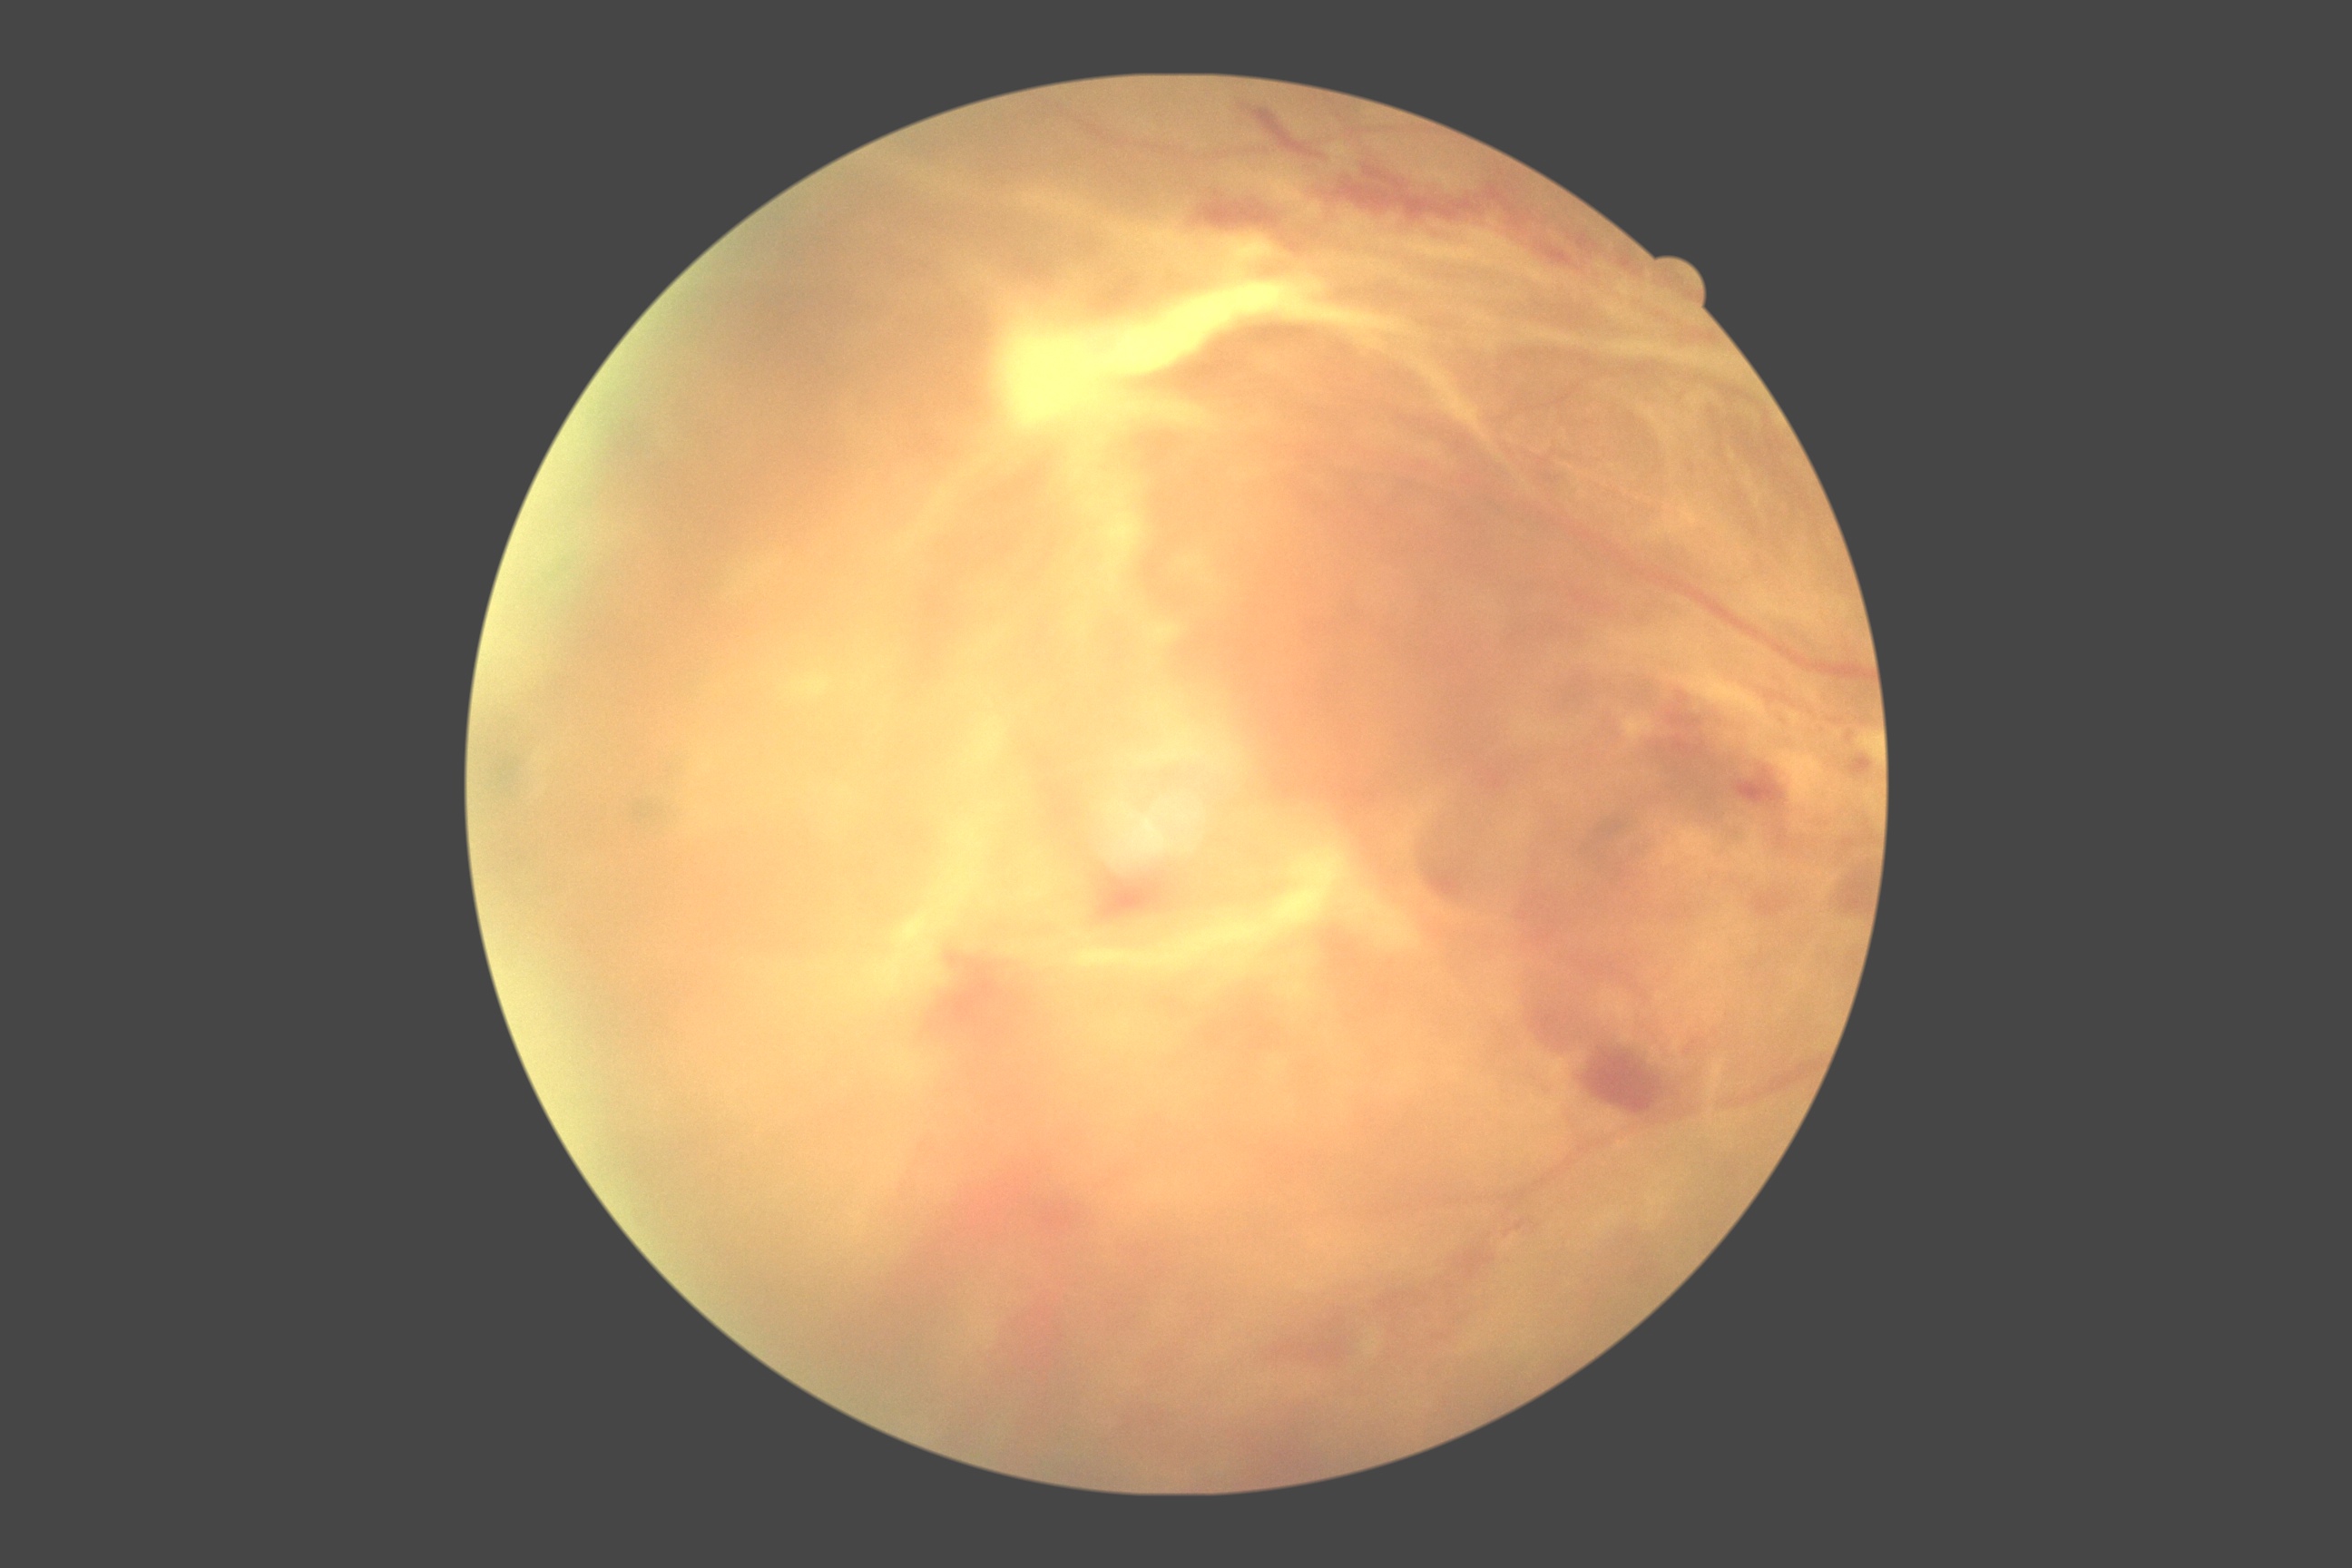
DR stage = PDR (grade 4)